Optic disc-centered crop
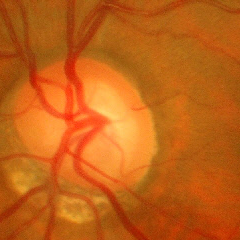
Q: What is the glaucoma diagnosis?
A: Yes — early-stage glaucoma.